Image size 1960x1897 — 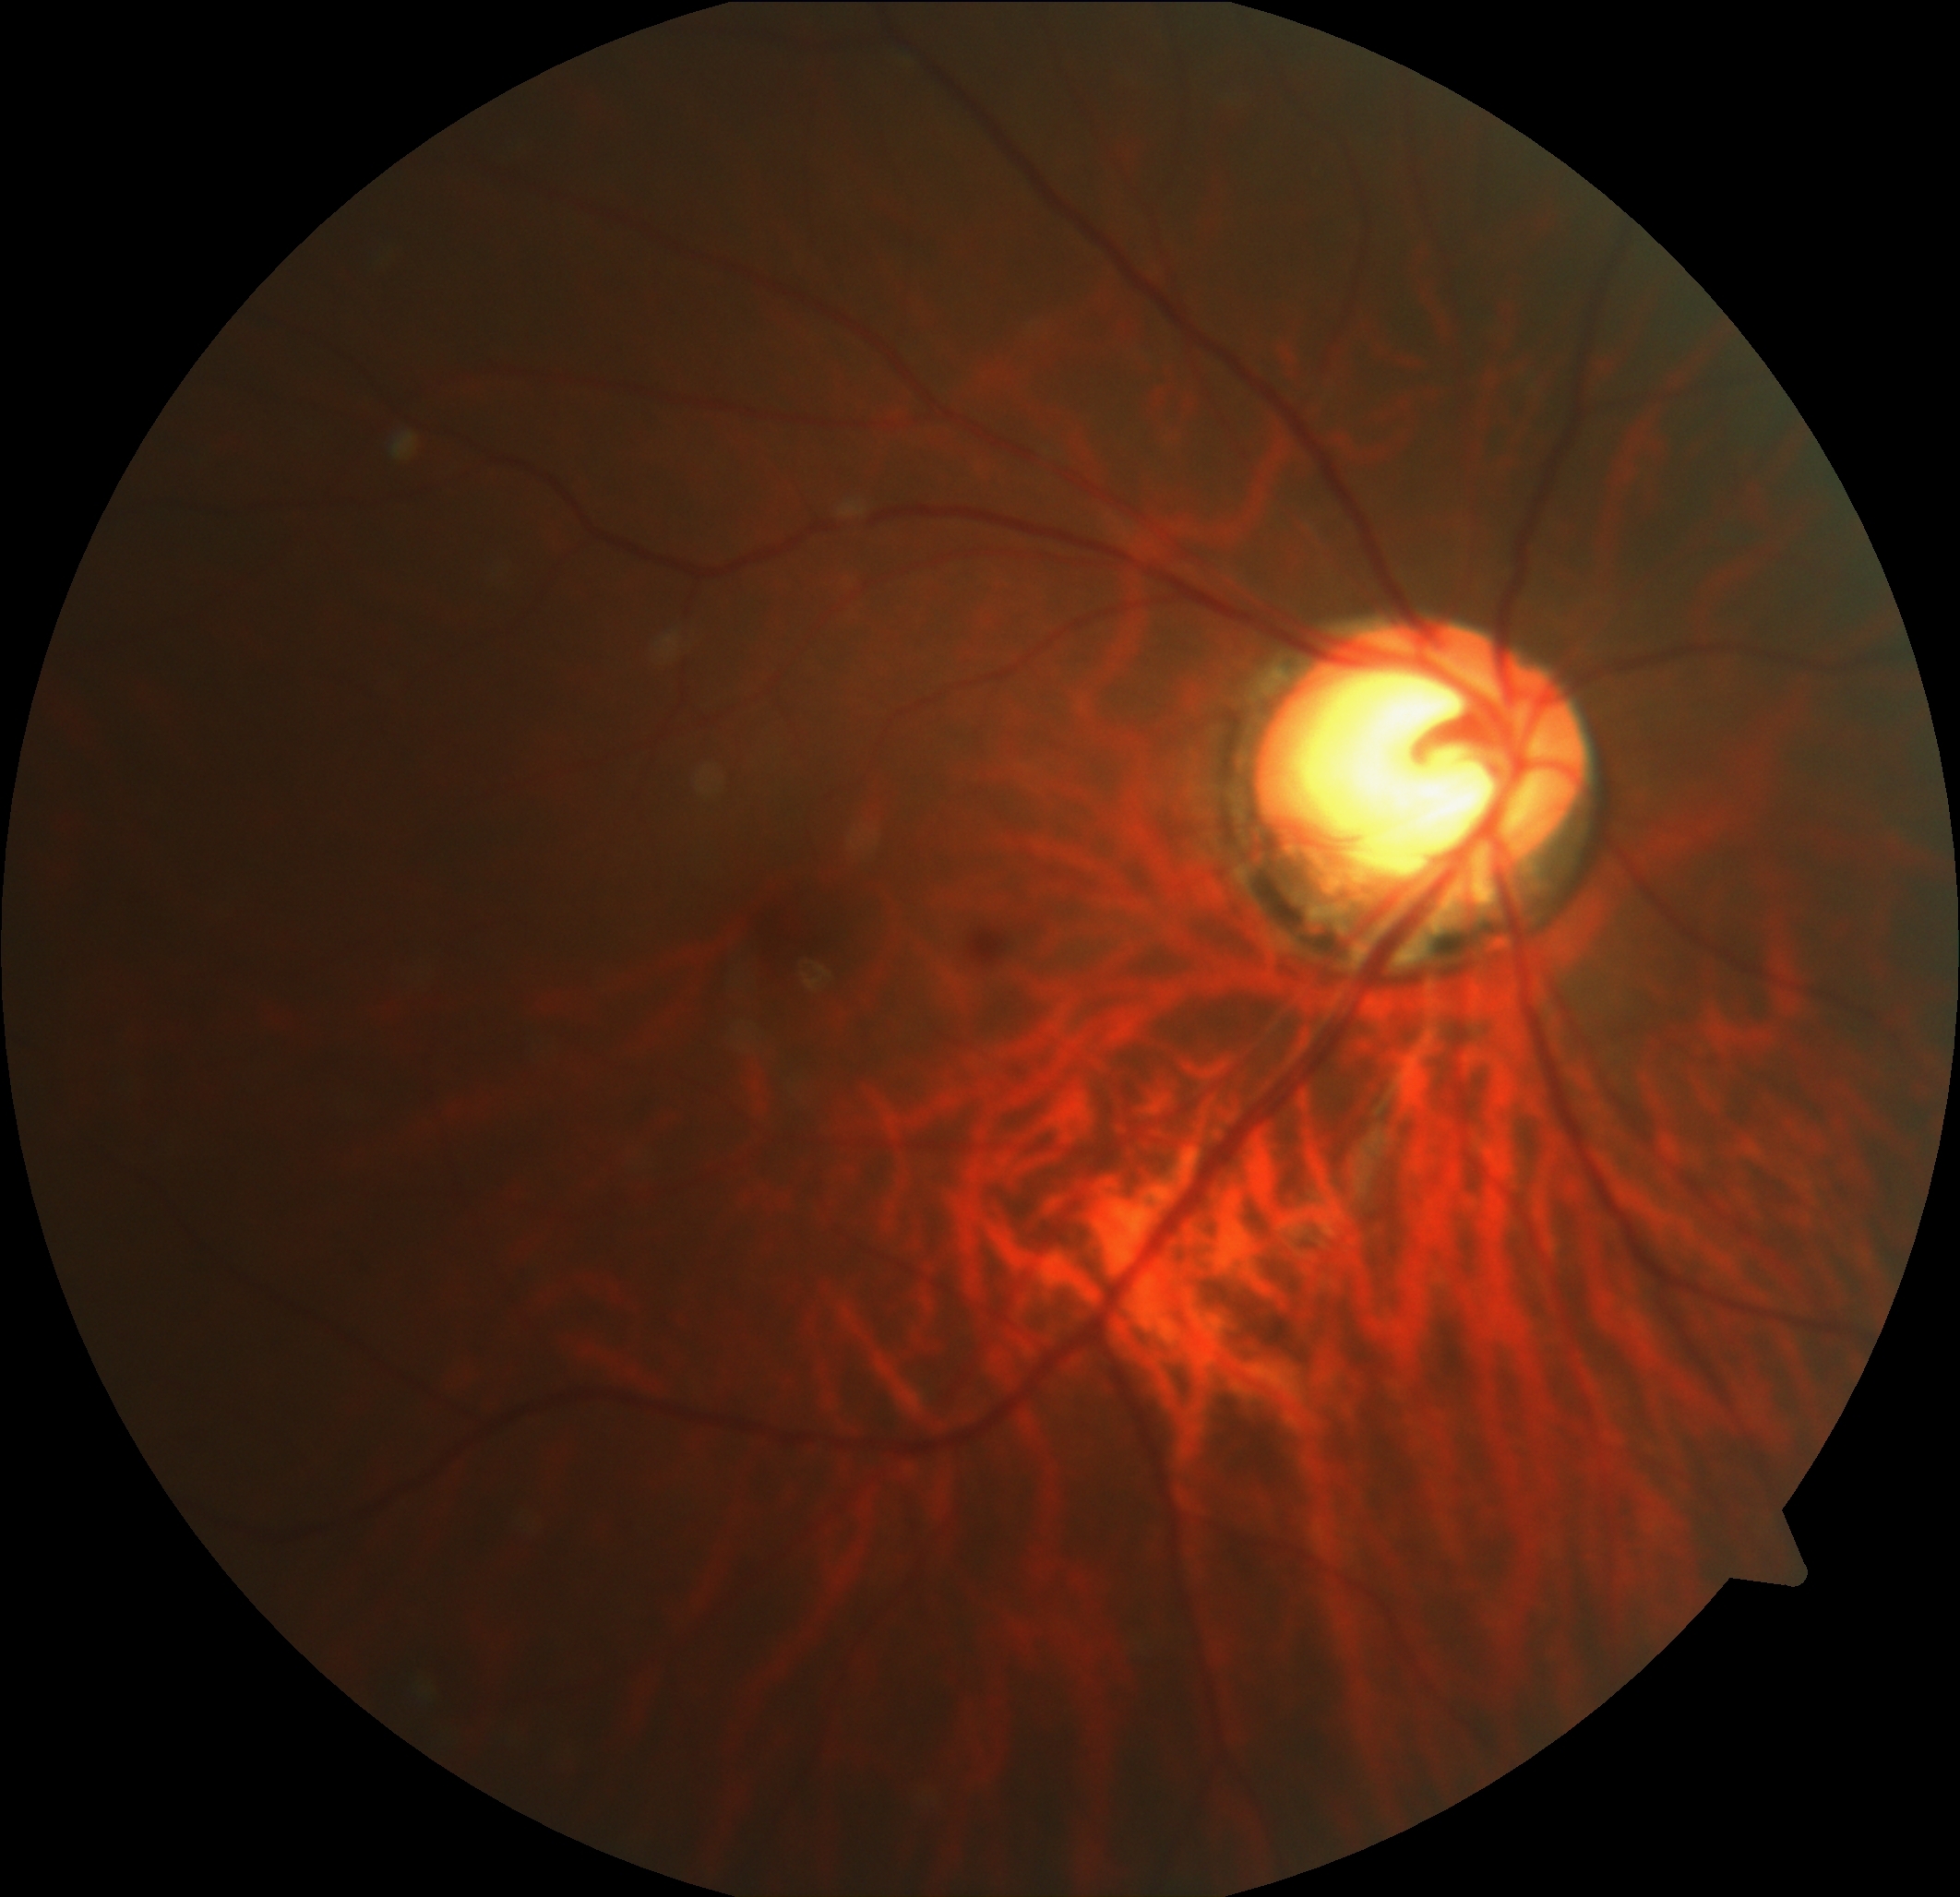

{"dr_impression": "negative for DR", "dr_grade": "no apparent retinopathy (grade 0)"}